Color fundus image:
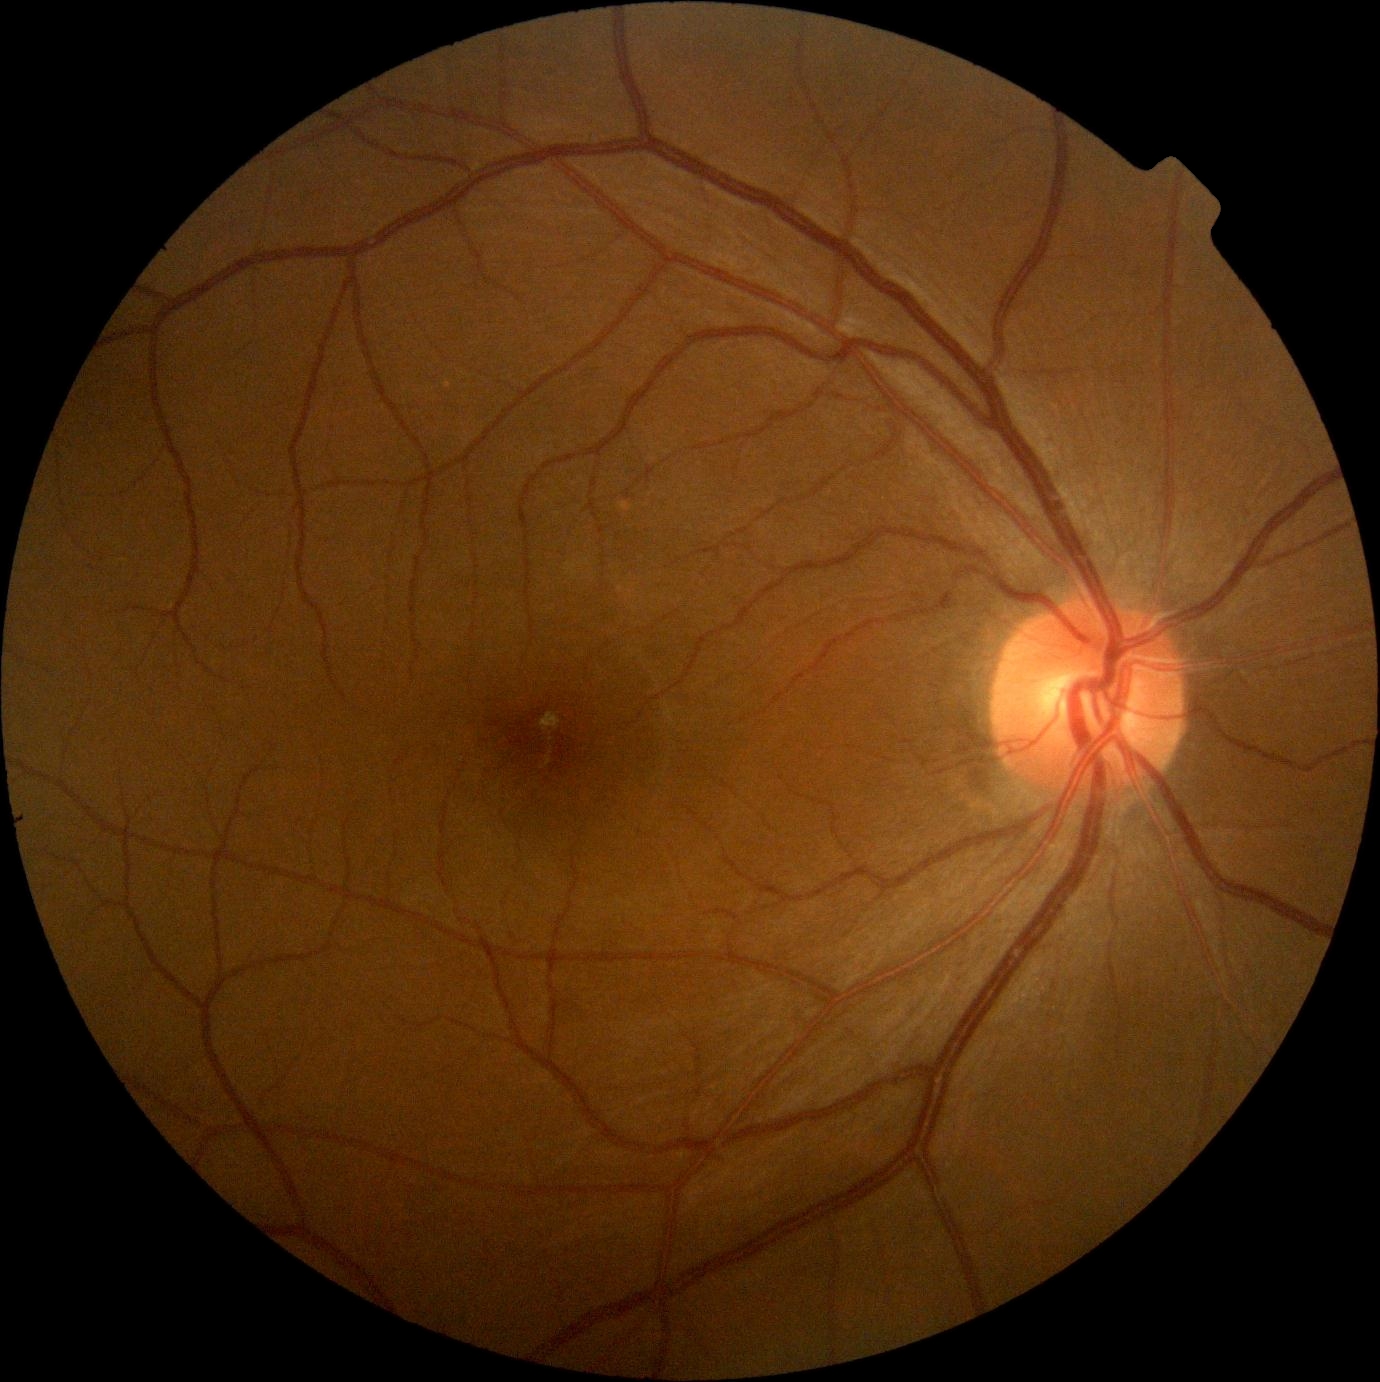 DR severity is 0/4. No DR findings.